CFP
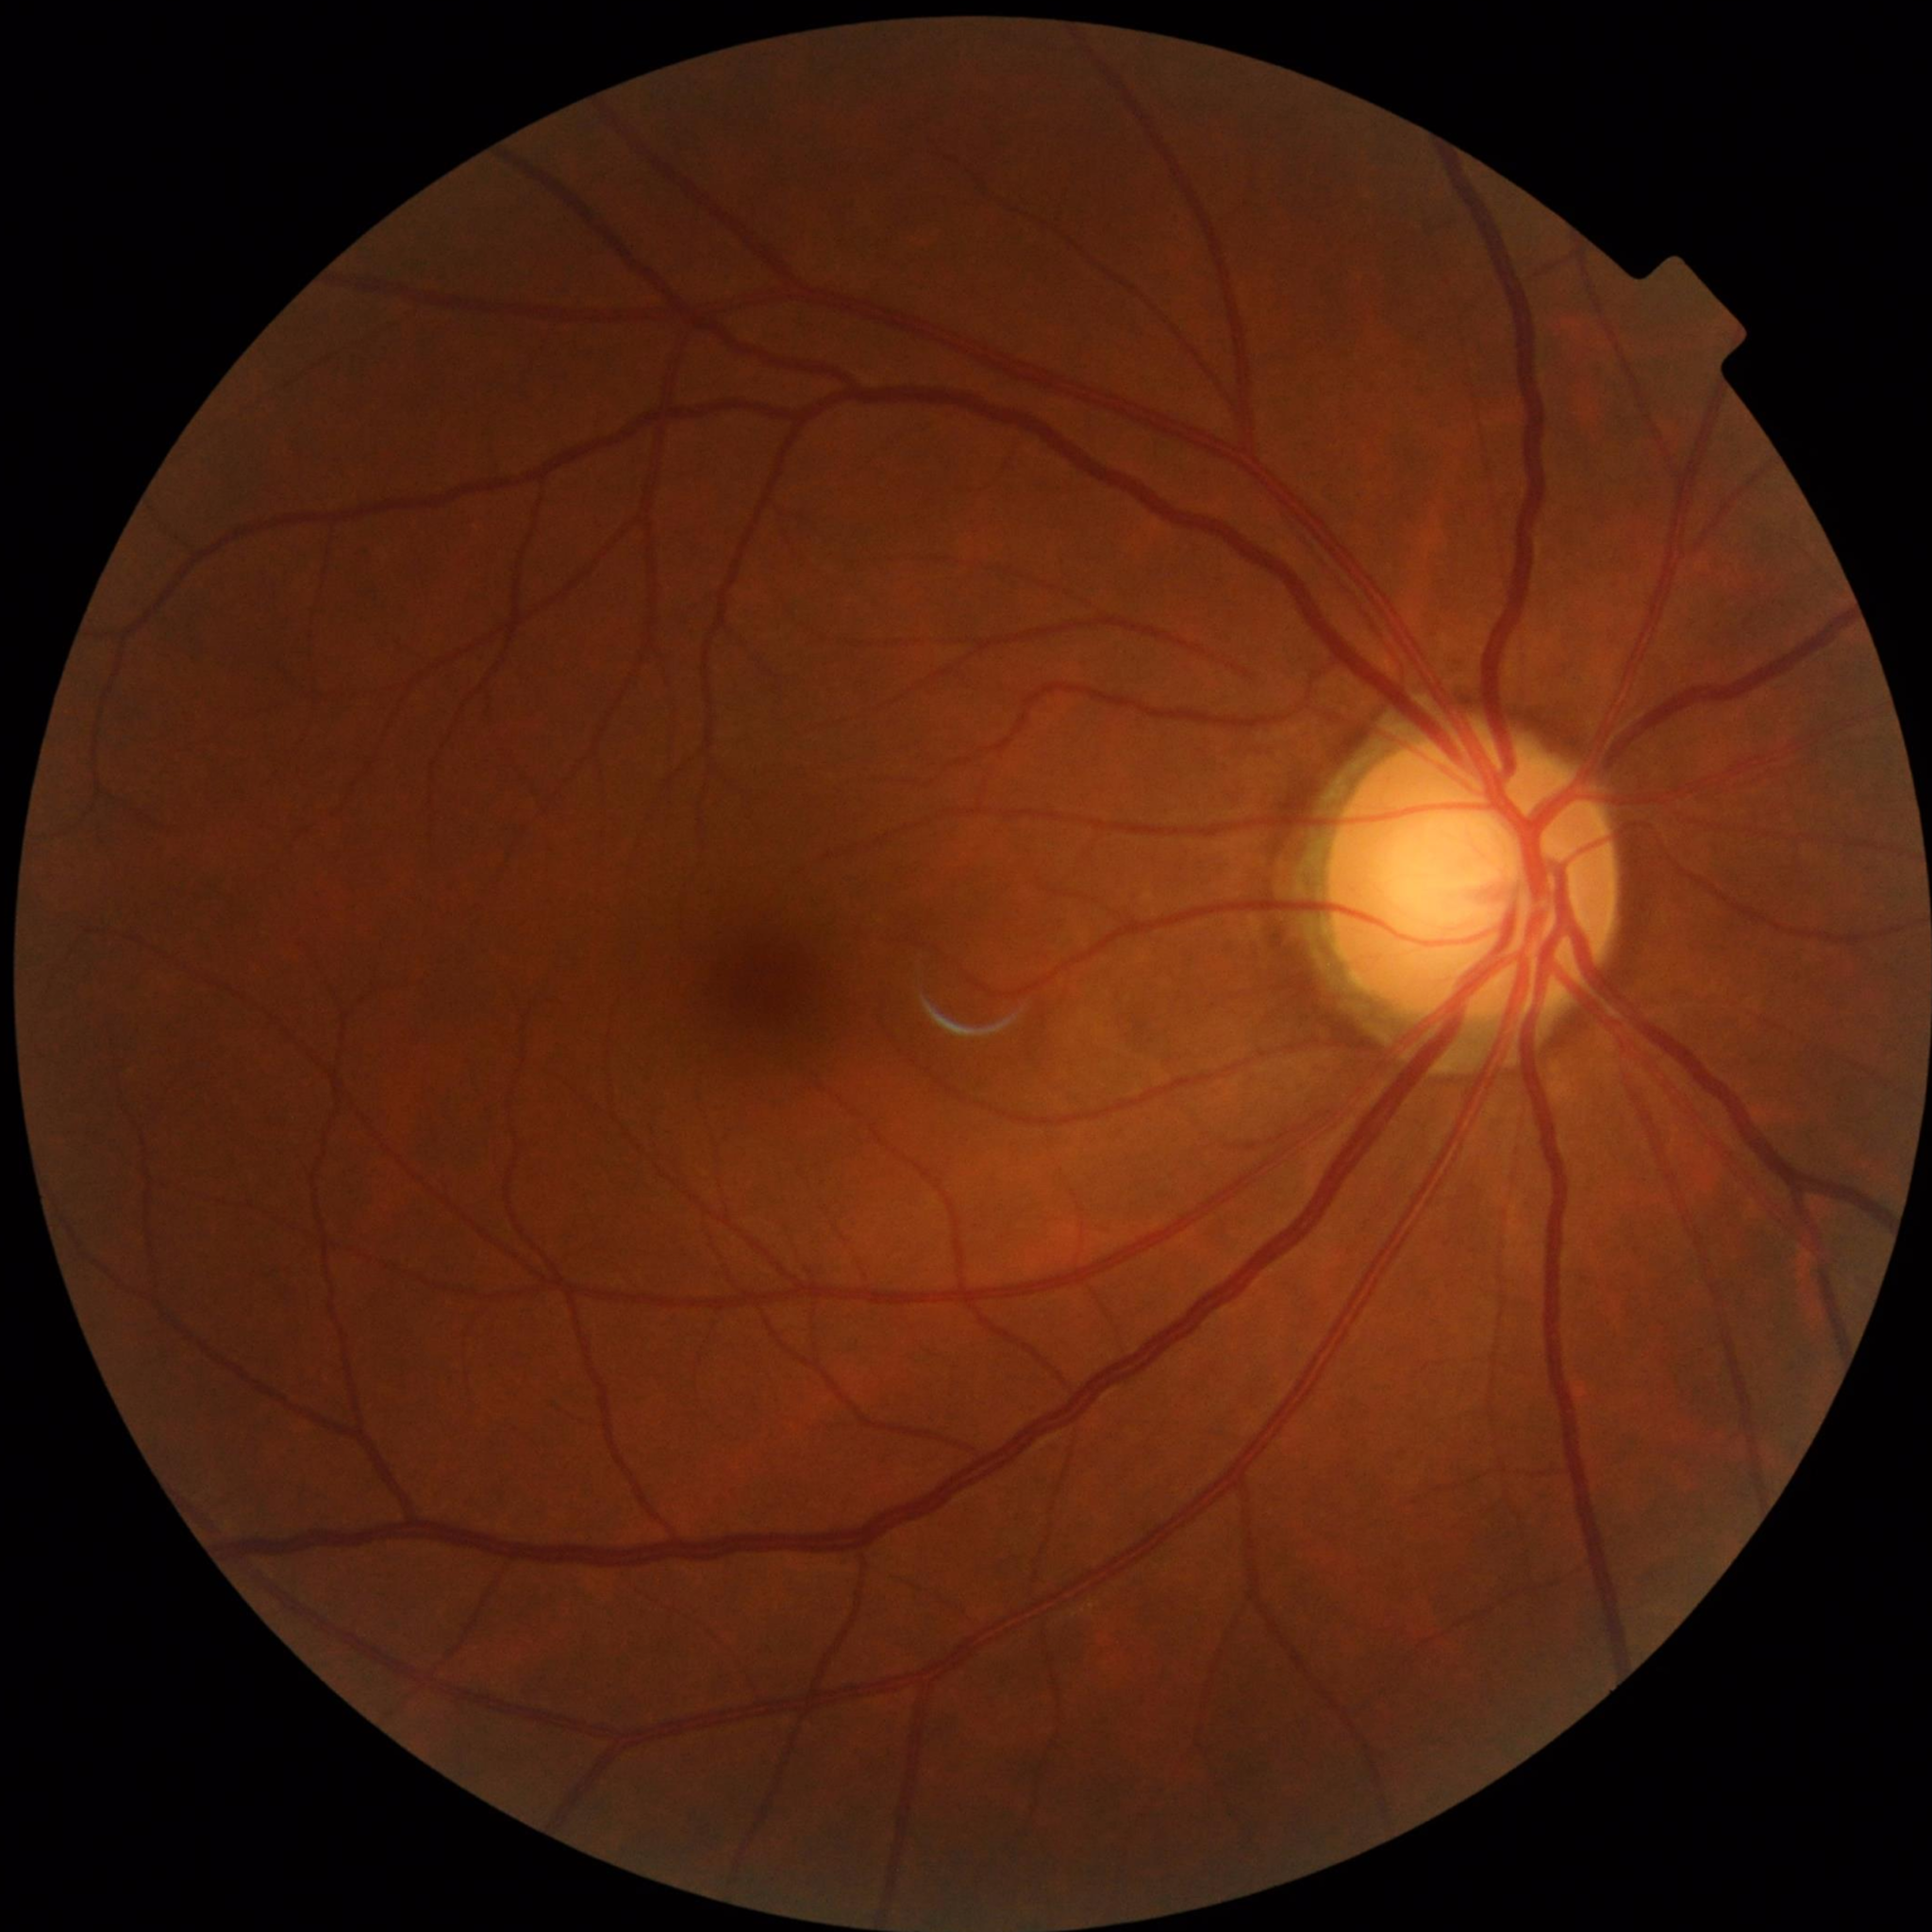
{"diagnosis": "control (no AMD/DR/glaucoma)"}